Camera: NIDEK AFC-230. 848 by 848 pixels:
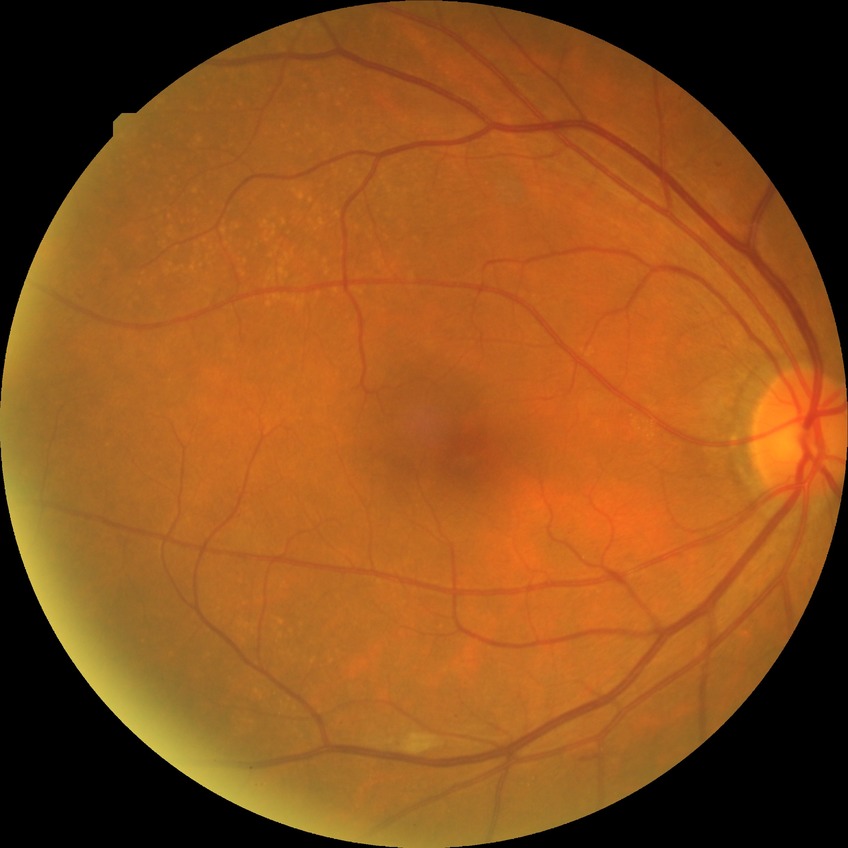
DR class: non-proliferative diabetic retinopathy; retinopathy grade: simple diabetic retinopathy.